Handheld portable fundus camera image: 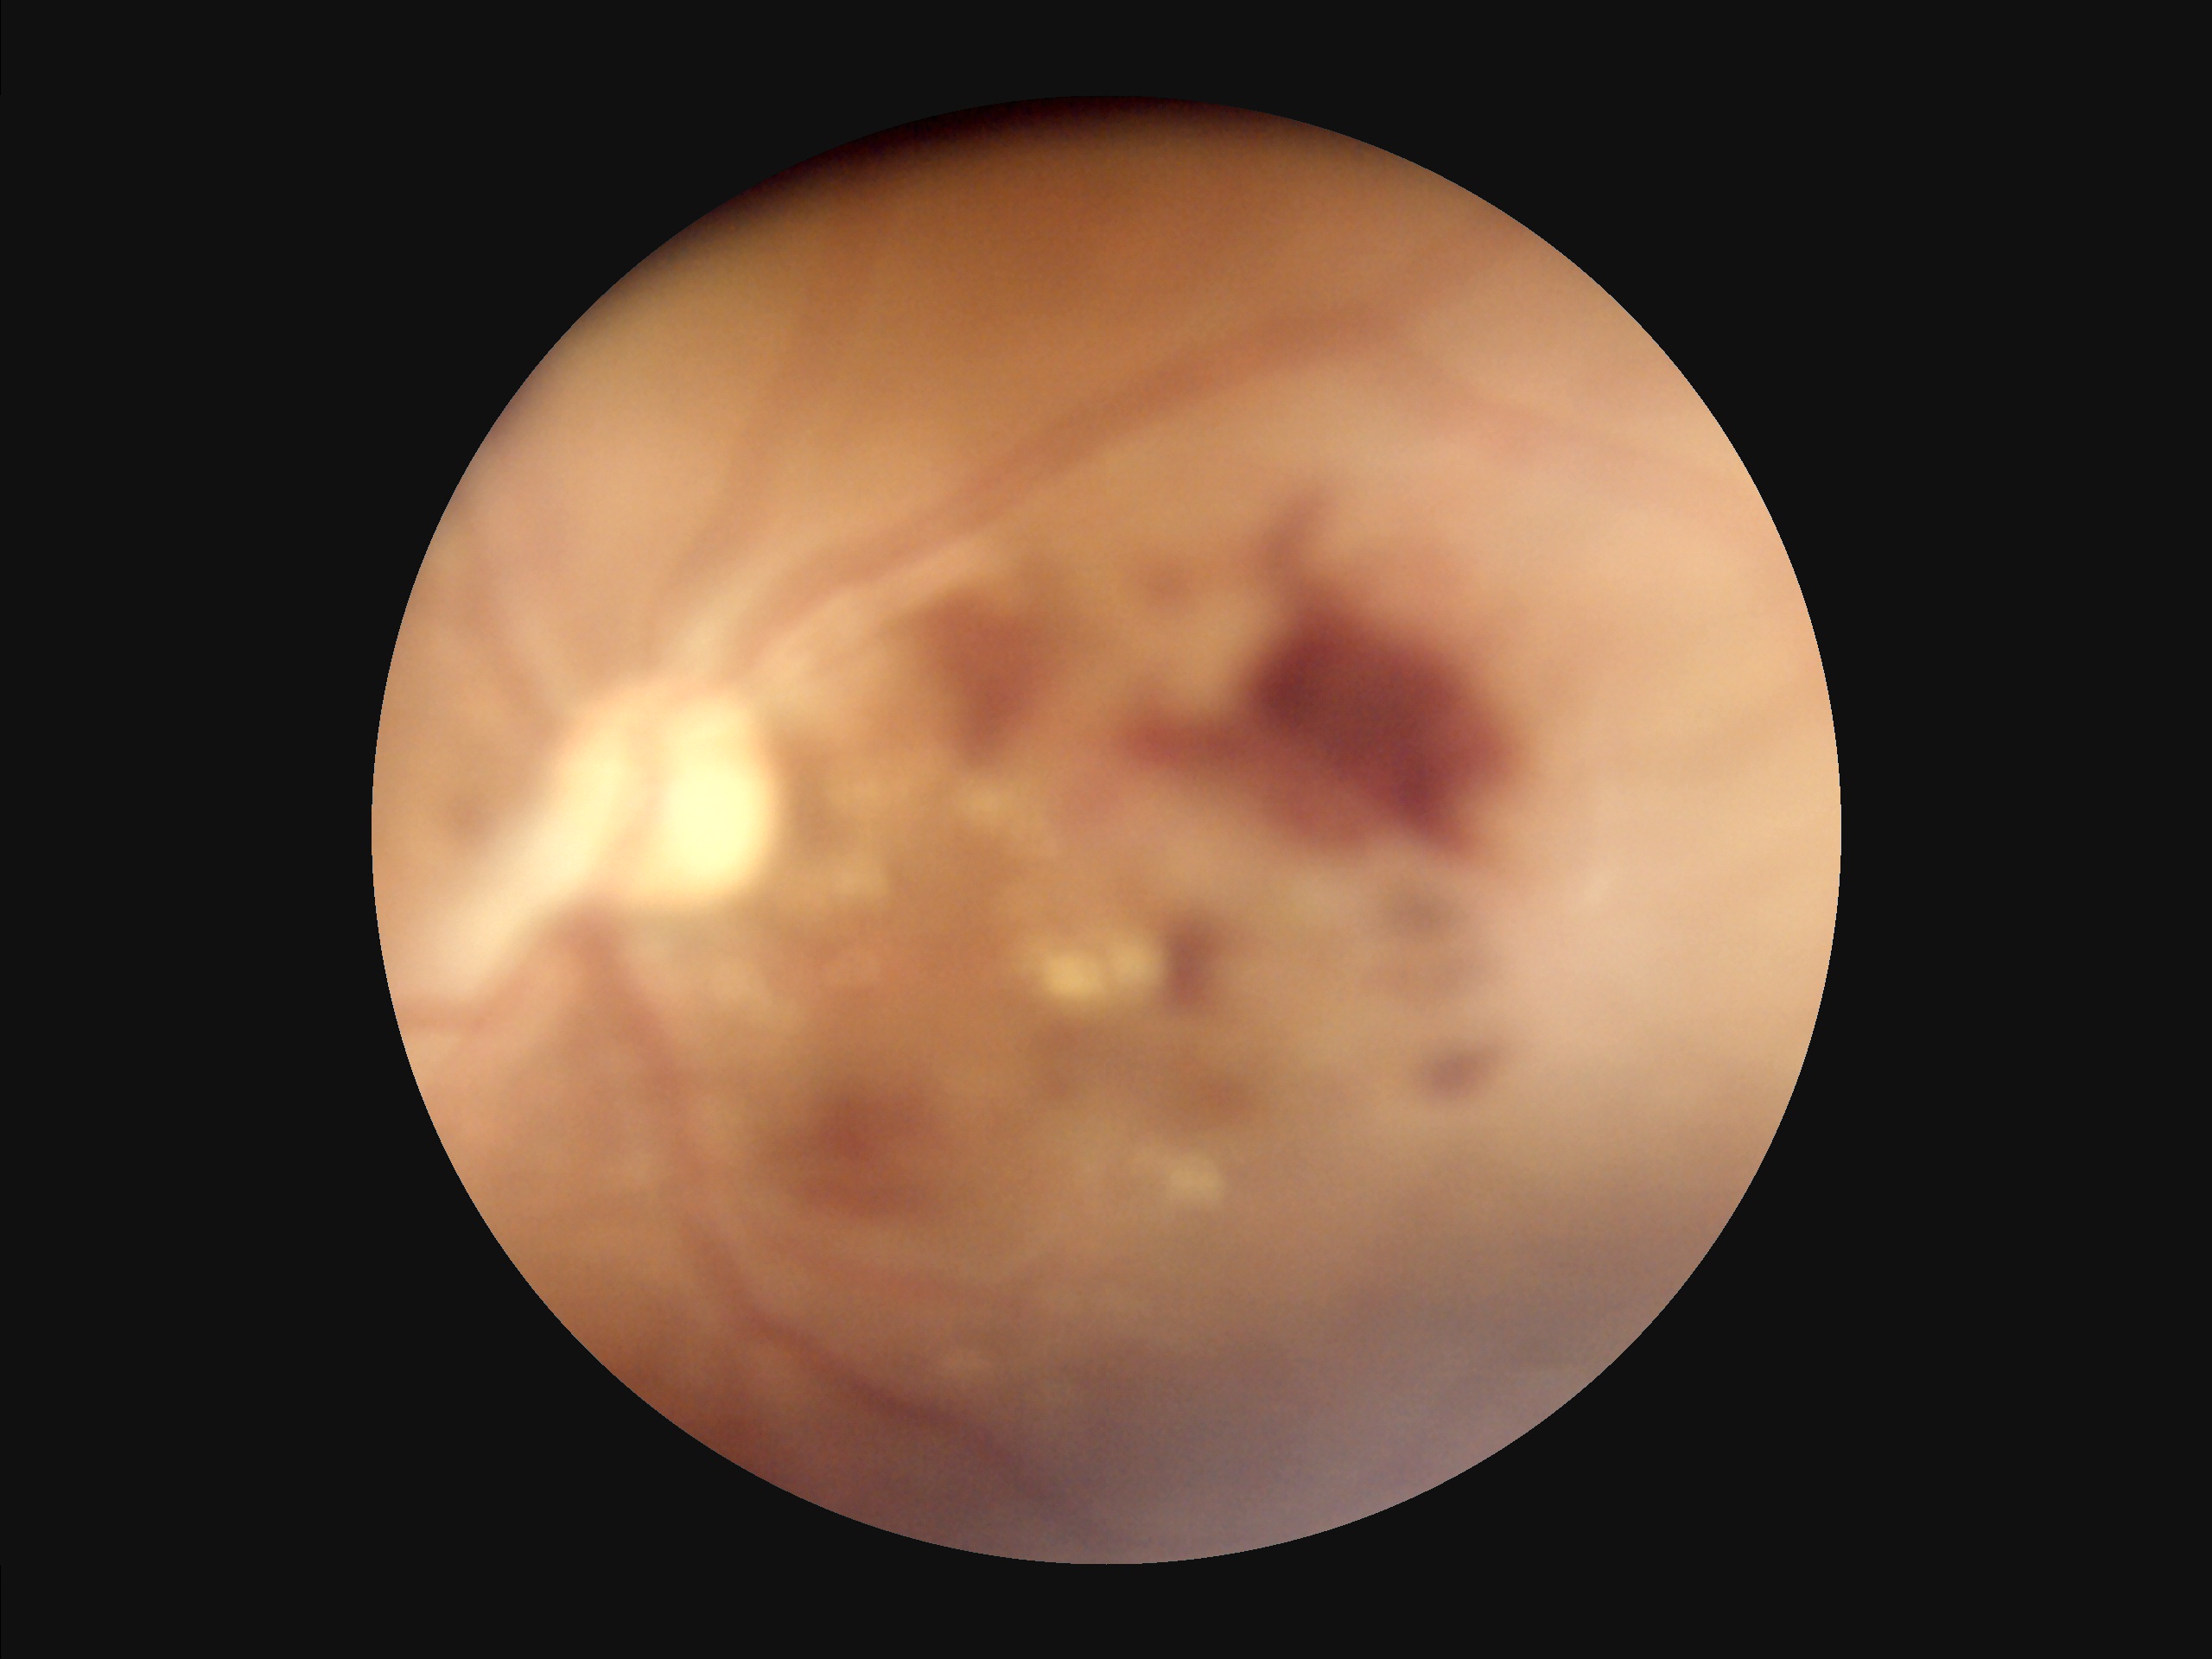

Adequate contrast for distinguishing structures.
Poor illumination with uneven exposure.
The image is blurry.
Overall image quality is poor.